Acquired with a NIDEK AFC-230; 45° field of view: 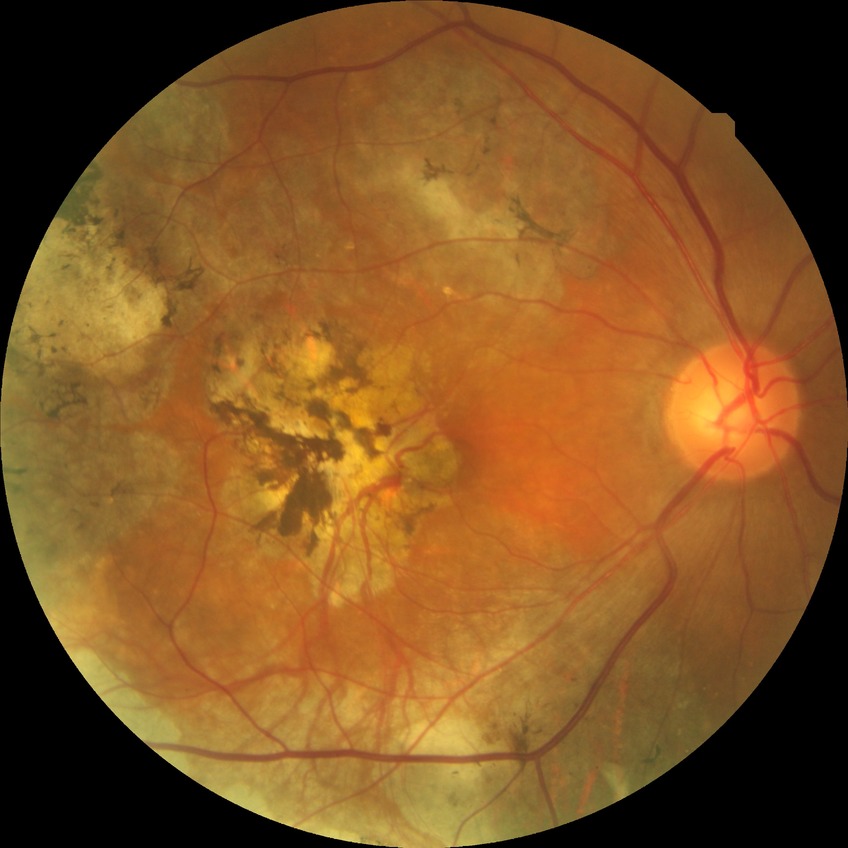 Diabetic retinopathy severity is no diabetic retinopathy.